Nonmydriatic fundus photograph.
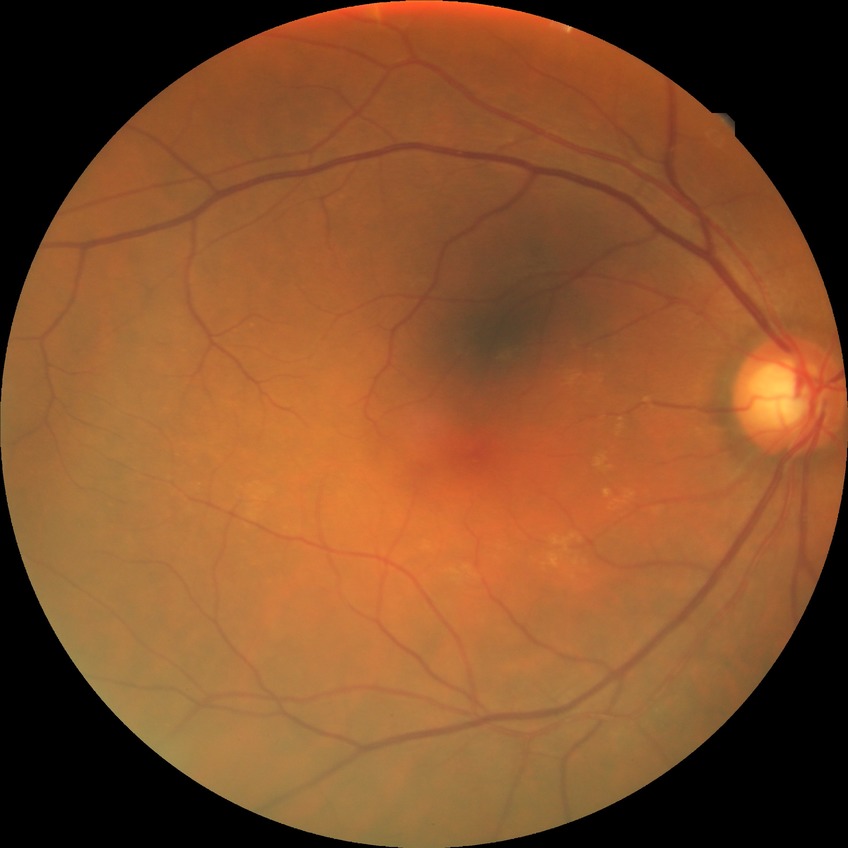 Diabetic retinopathy (DR) is no diabetic retinopathy (NDR).